Wide-field fundus photograph from neonatal ROP screening:
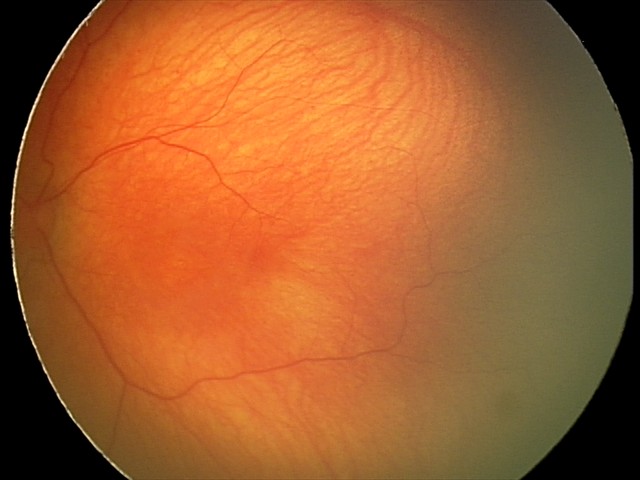 Screening examination with no abnormal retinal findings.